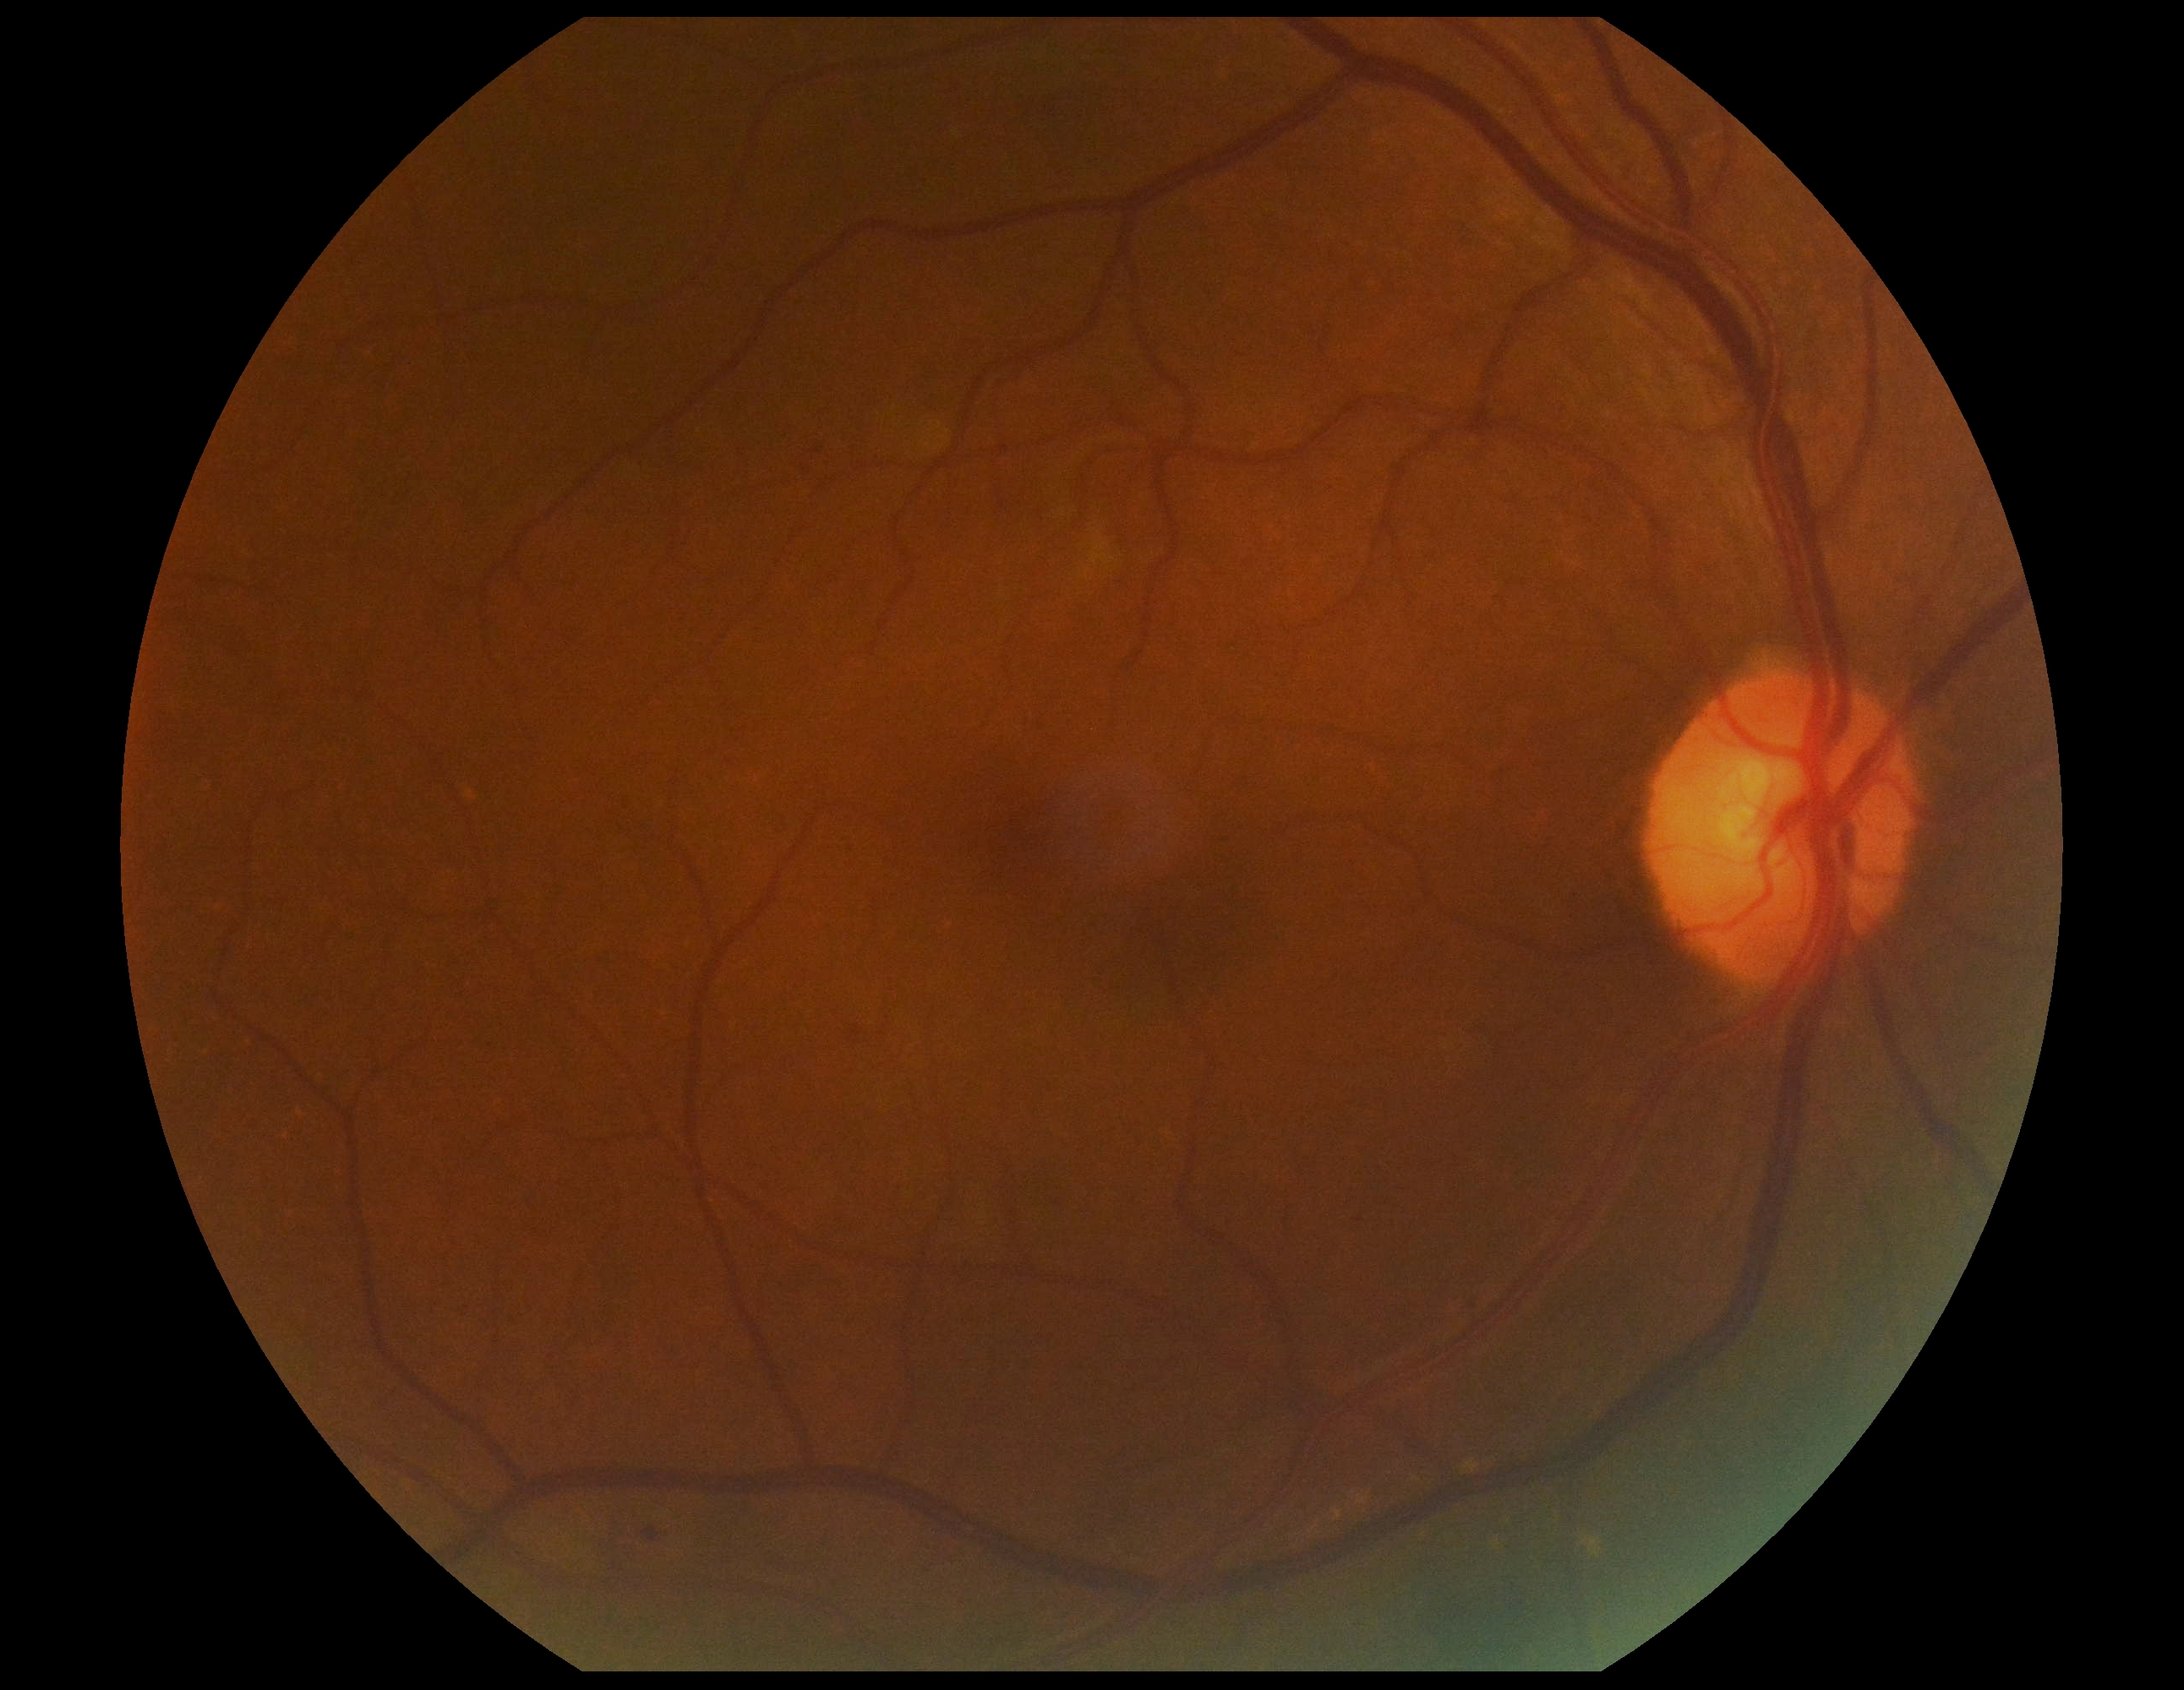

DR severity=moderate non-proliferative diabetic retinopathy (grade 2).